Retinal fundus photograph · 2346x1568px: 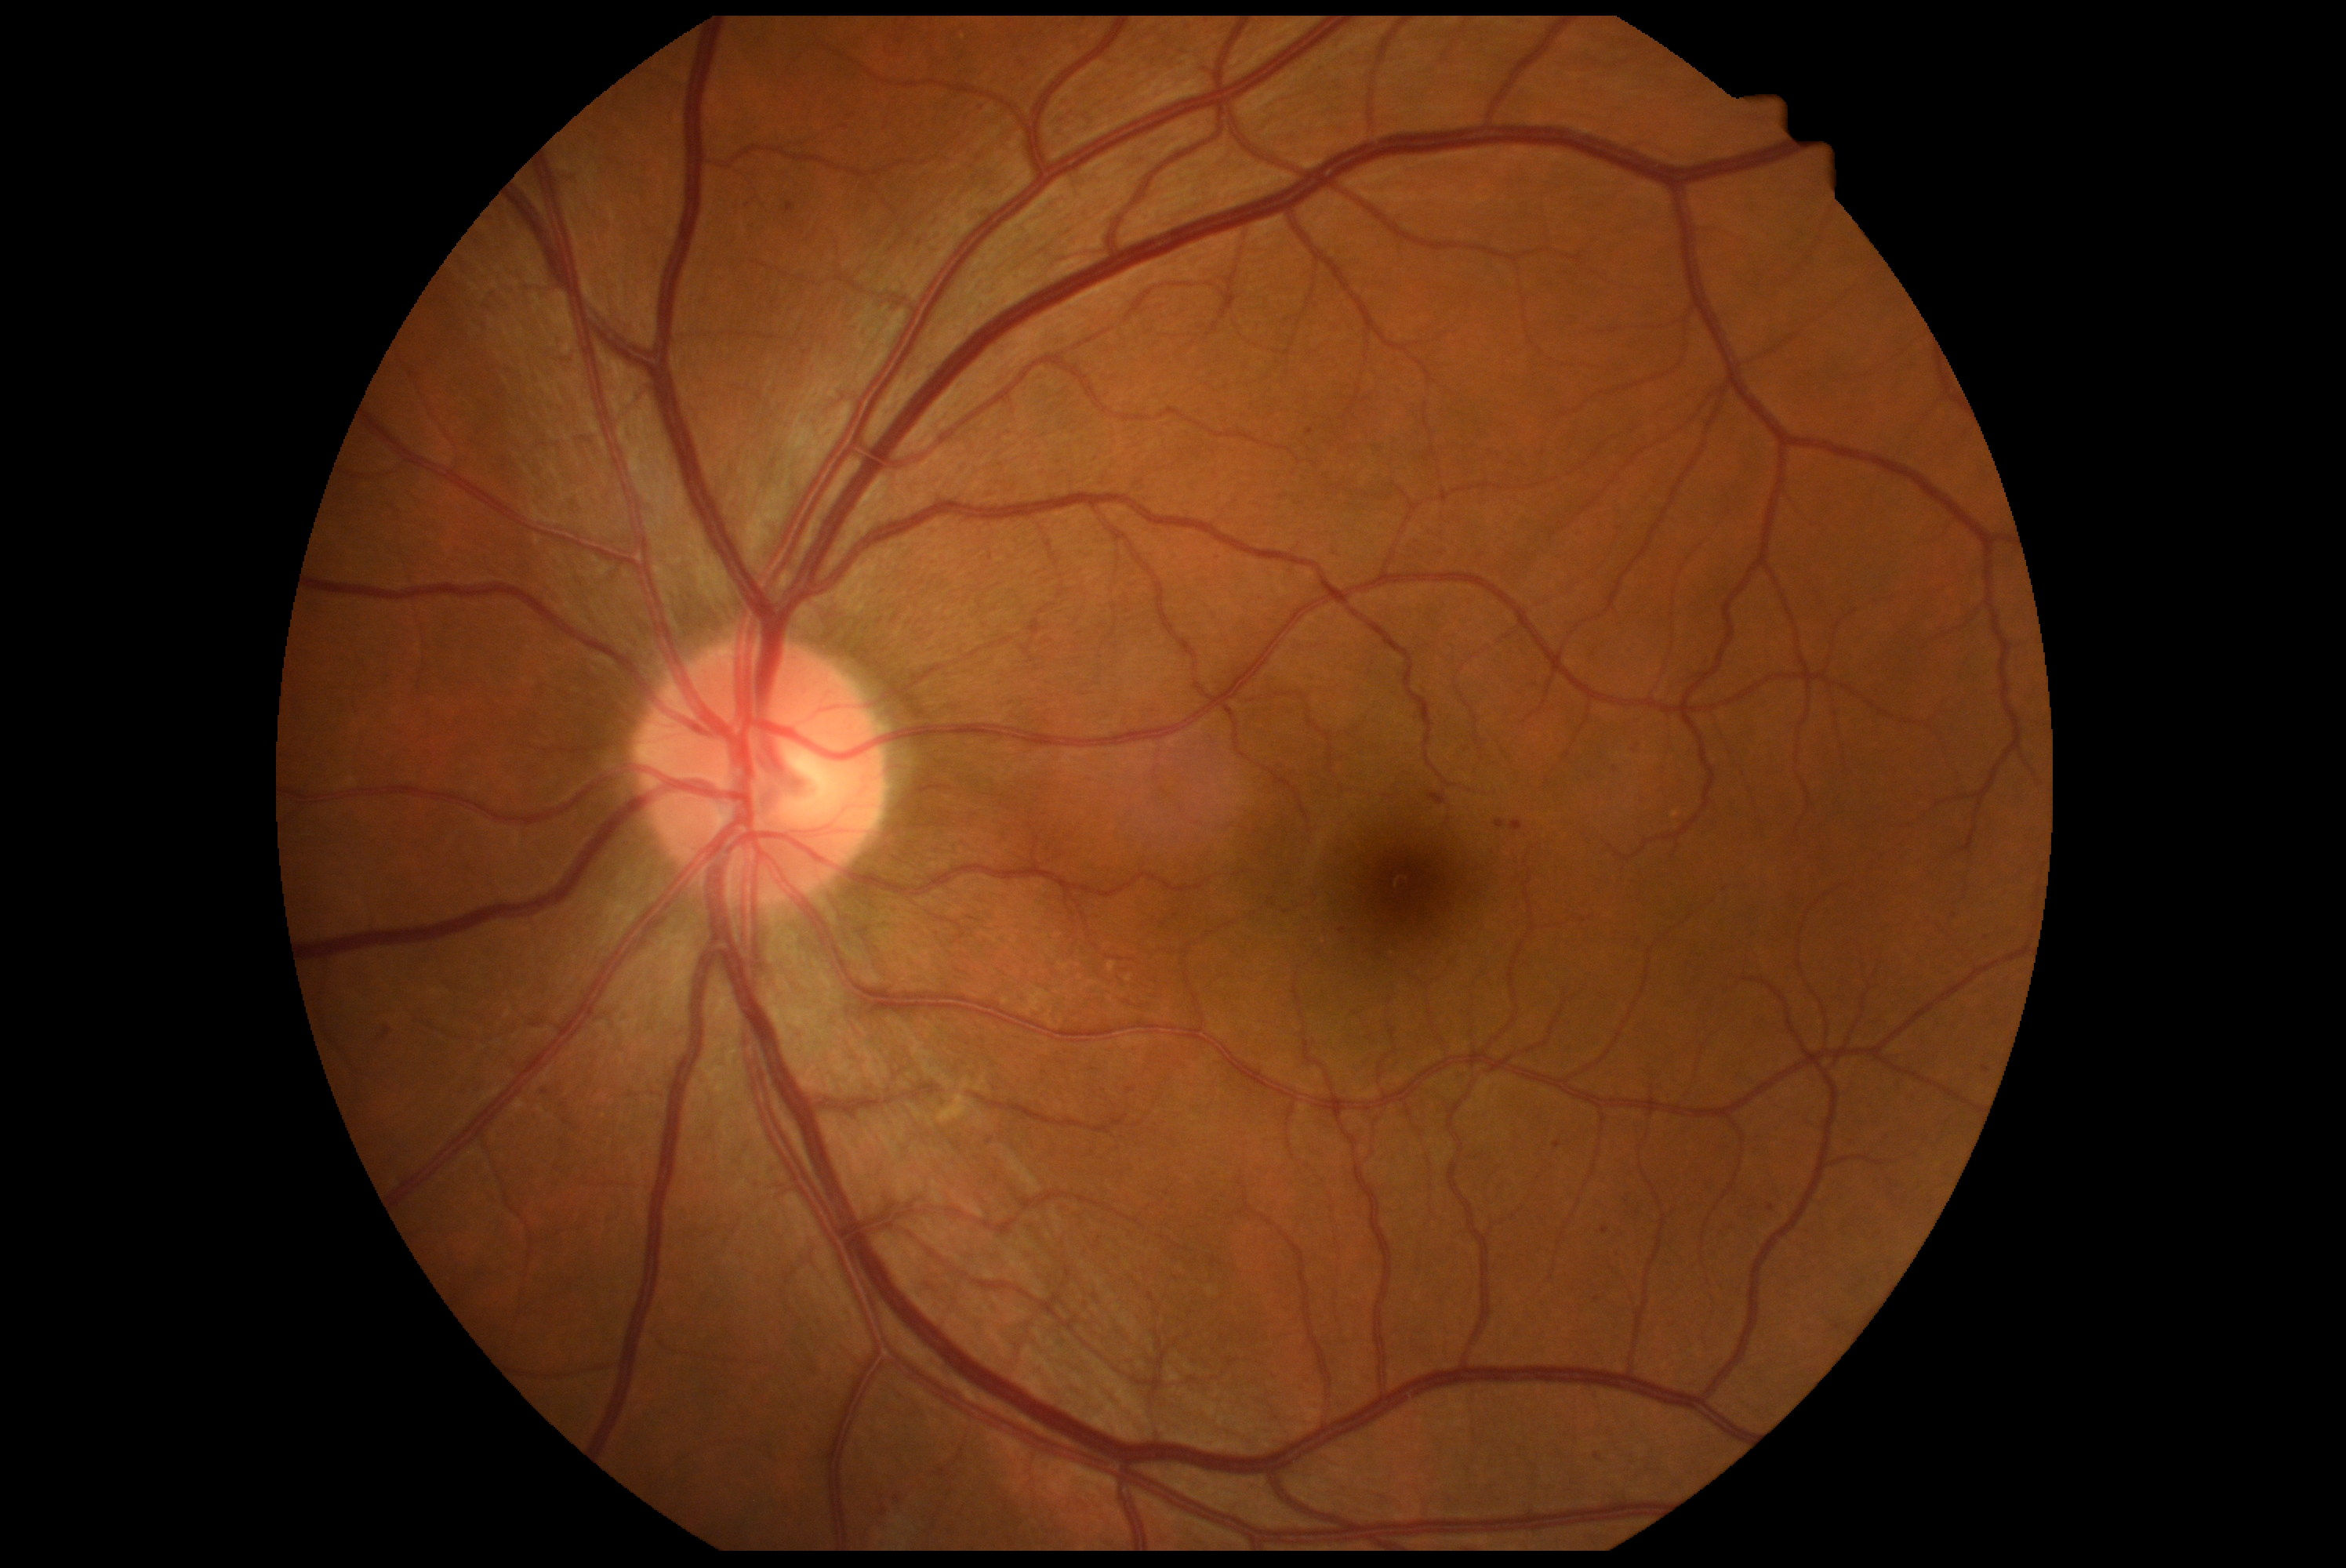 Findings:
– retinopathy grade — moderate NPDR (2) — more than just microaneurysms but less than severe NPDR